Camera: Clarity RetCam 3 (130° FOV); pediatric retinal photograph (wide-field)
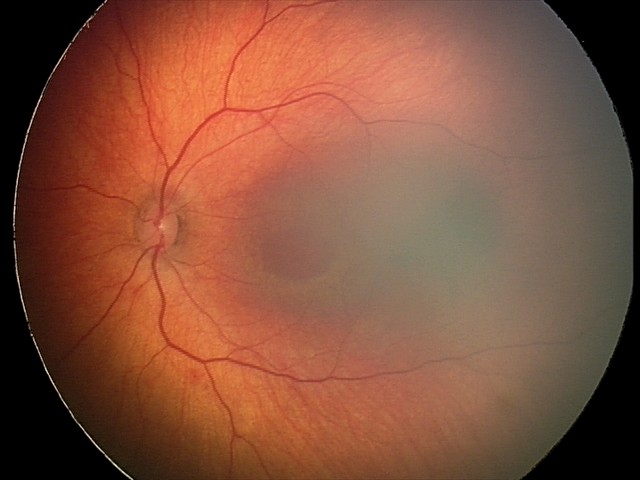 Assessment = retinal hemorrhages